Wide-field fundus photograph from neonatal ROP screening
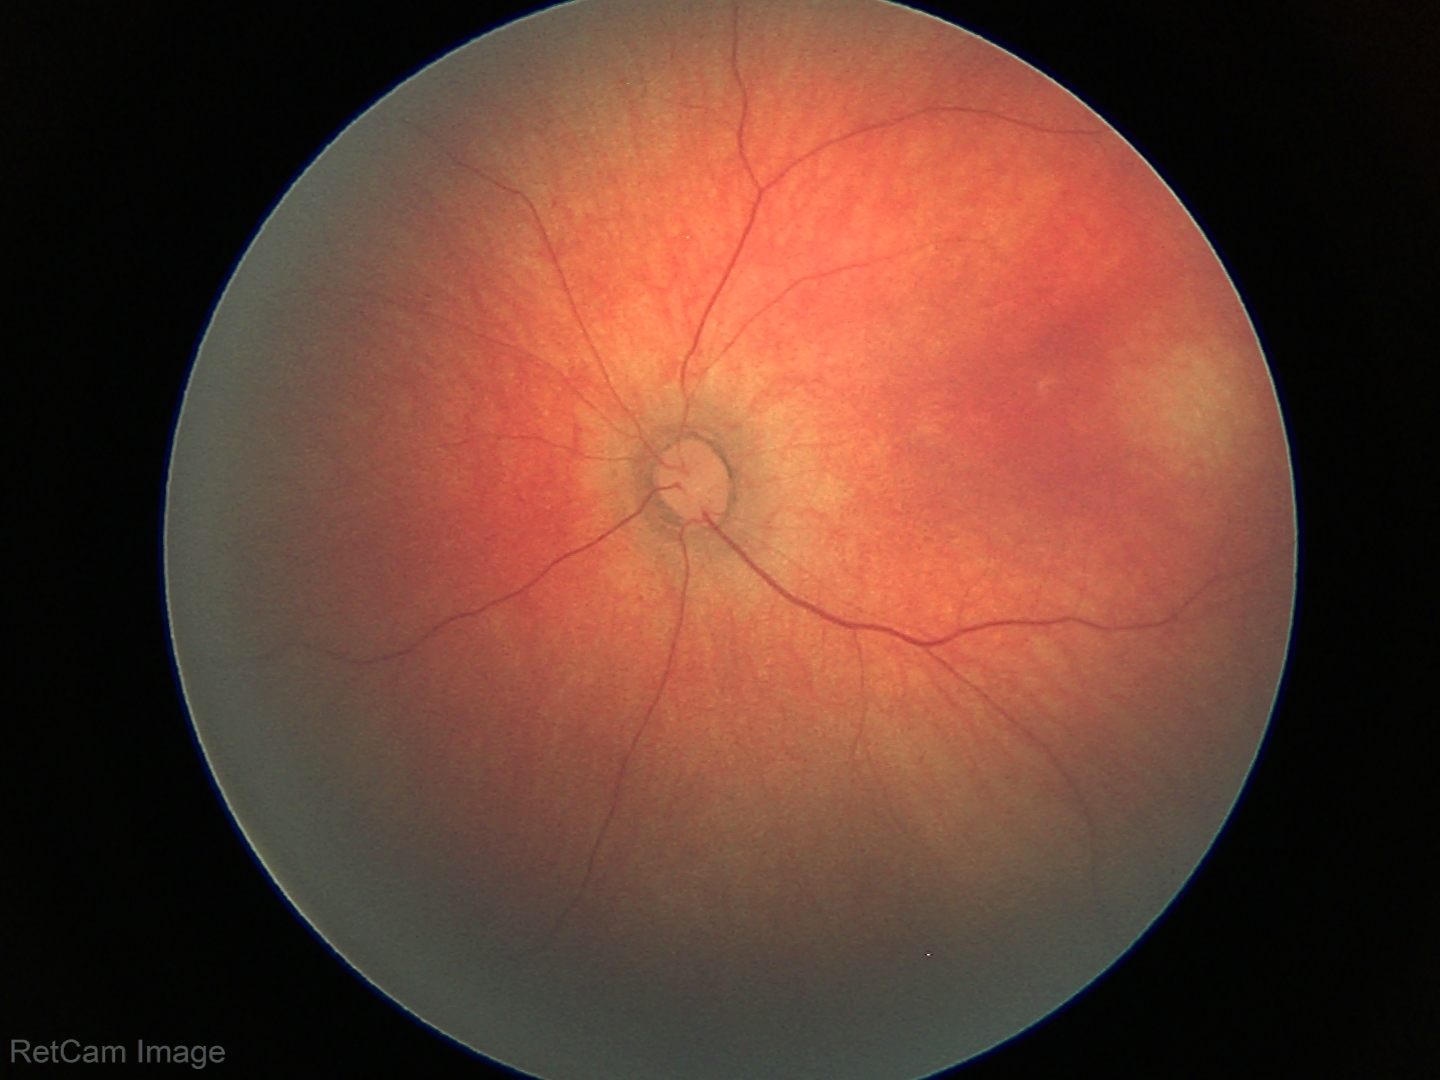 Screening diagnosis: normal retinal appearance.